45-degree field of view, nonmydriatic fundus photograph: 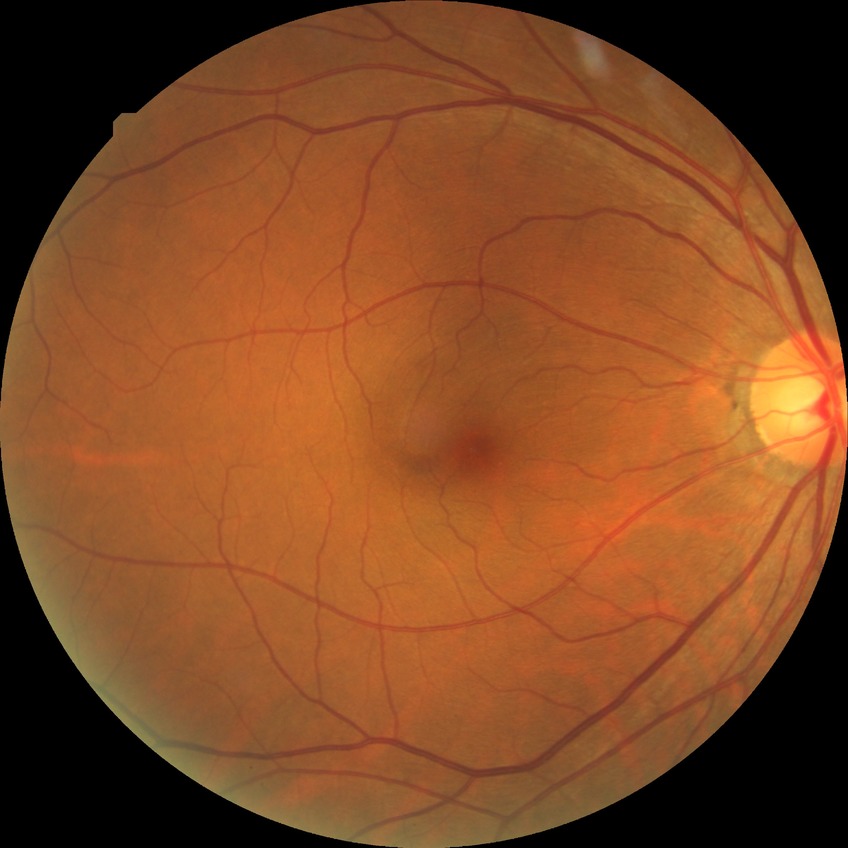 • modified Davis grading — no diabetic retinopathy